Pediatric retinal photograph (wide-field).
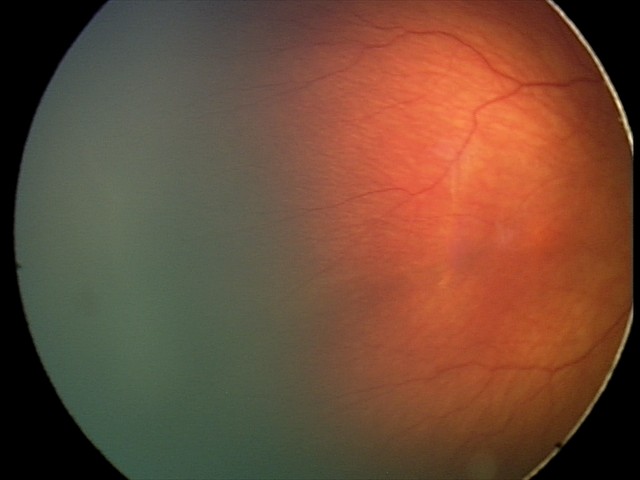 Without plus disease. Screening examination consistent with retinopathy of prematurity stage 2.